2089x1764 — 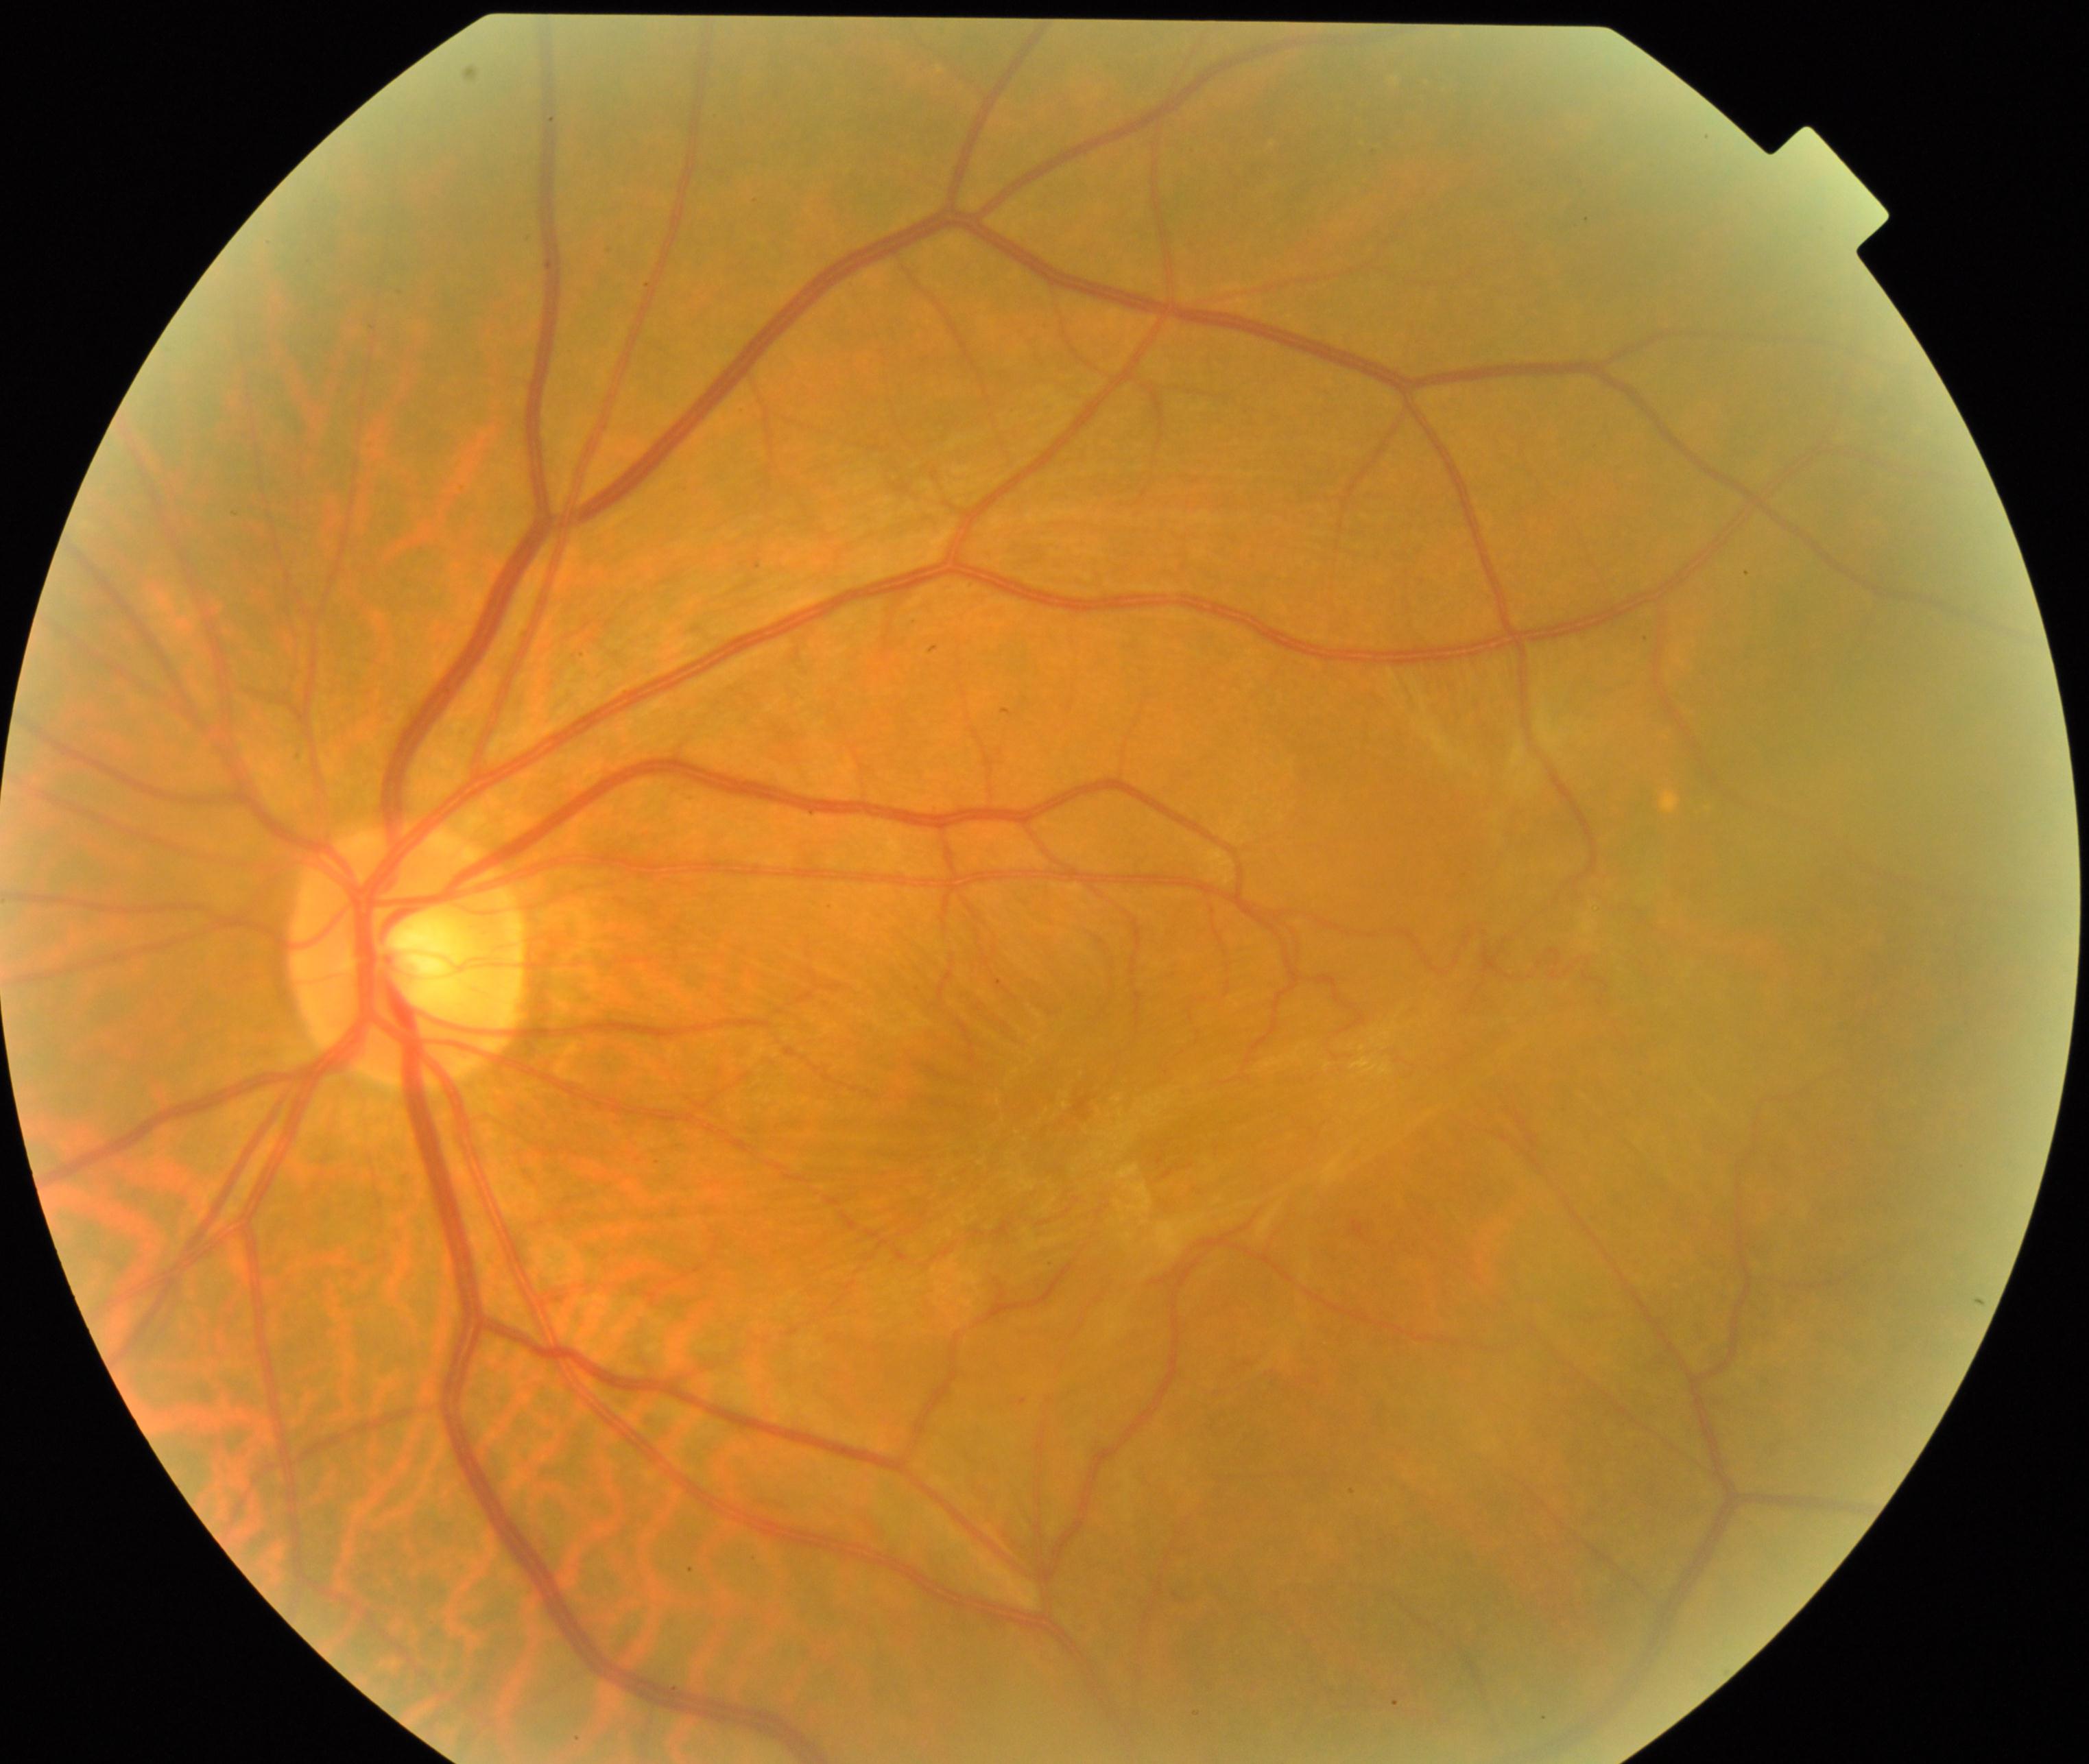

Fundus appearance consistent with epiretinal membrane. Typically showing a cellophane-sheen sheet on or above the surface of the retina with macular pucker and distortion of blood vessels within the vessel arcades.